Wide-field fundus photograph from neonatal ROP screening: 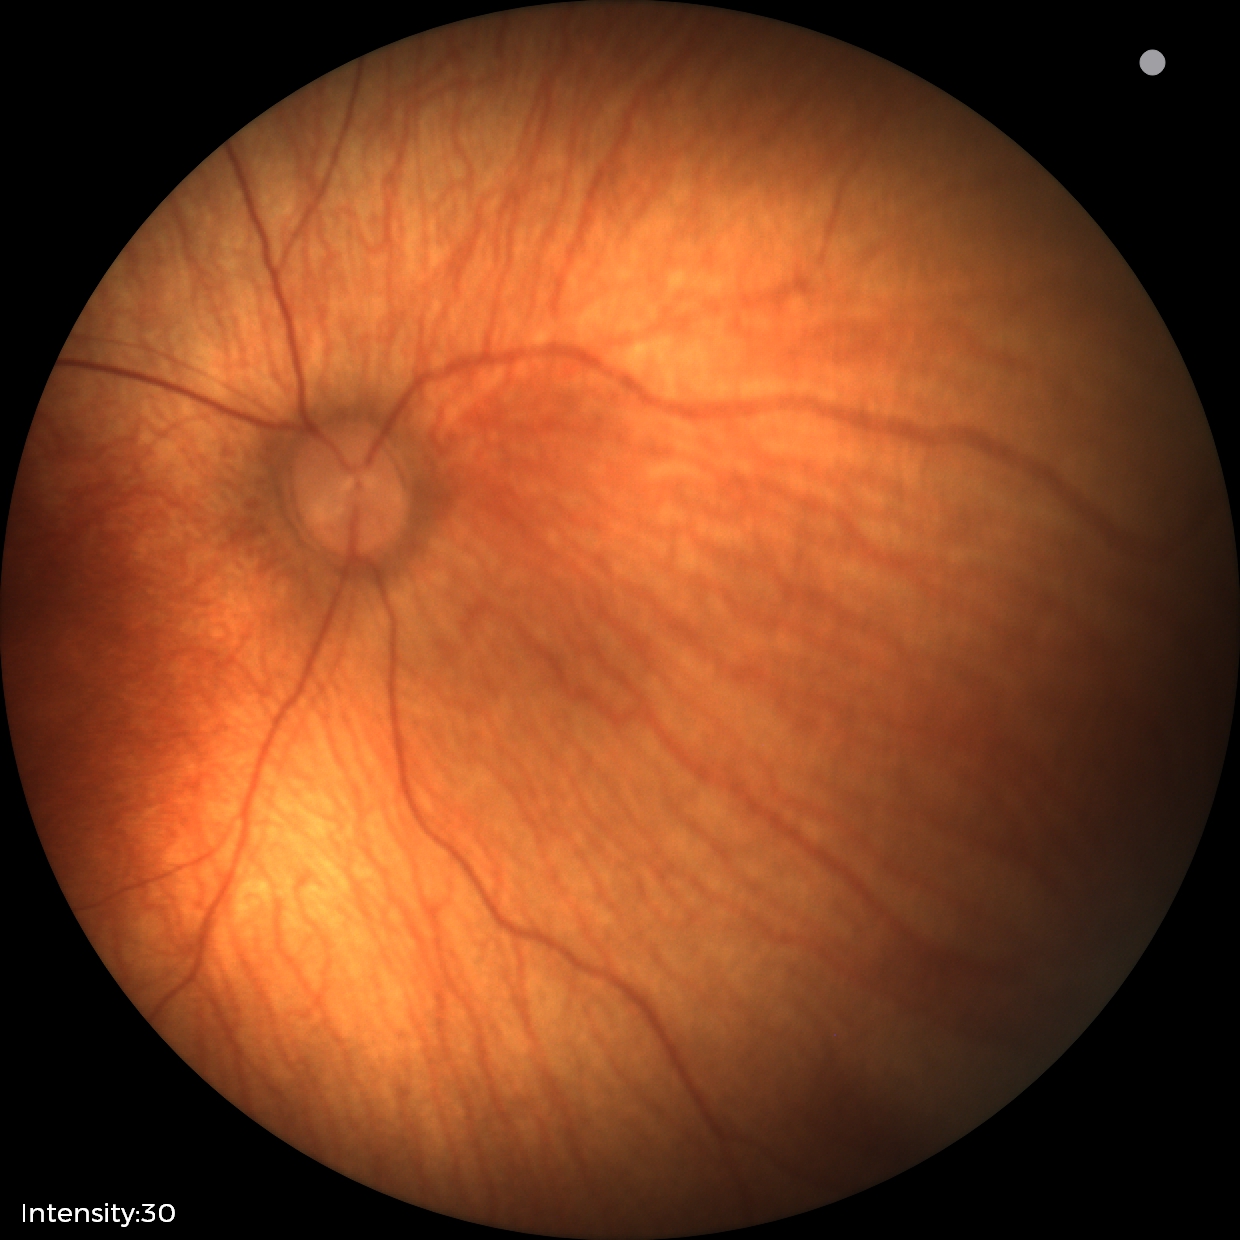
Screening examination with no abnormal retinal findings.